Wide-field fundus photograph of an infant; captured with the Phoenix ICON (100° field of view); 1240x1240.
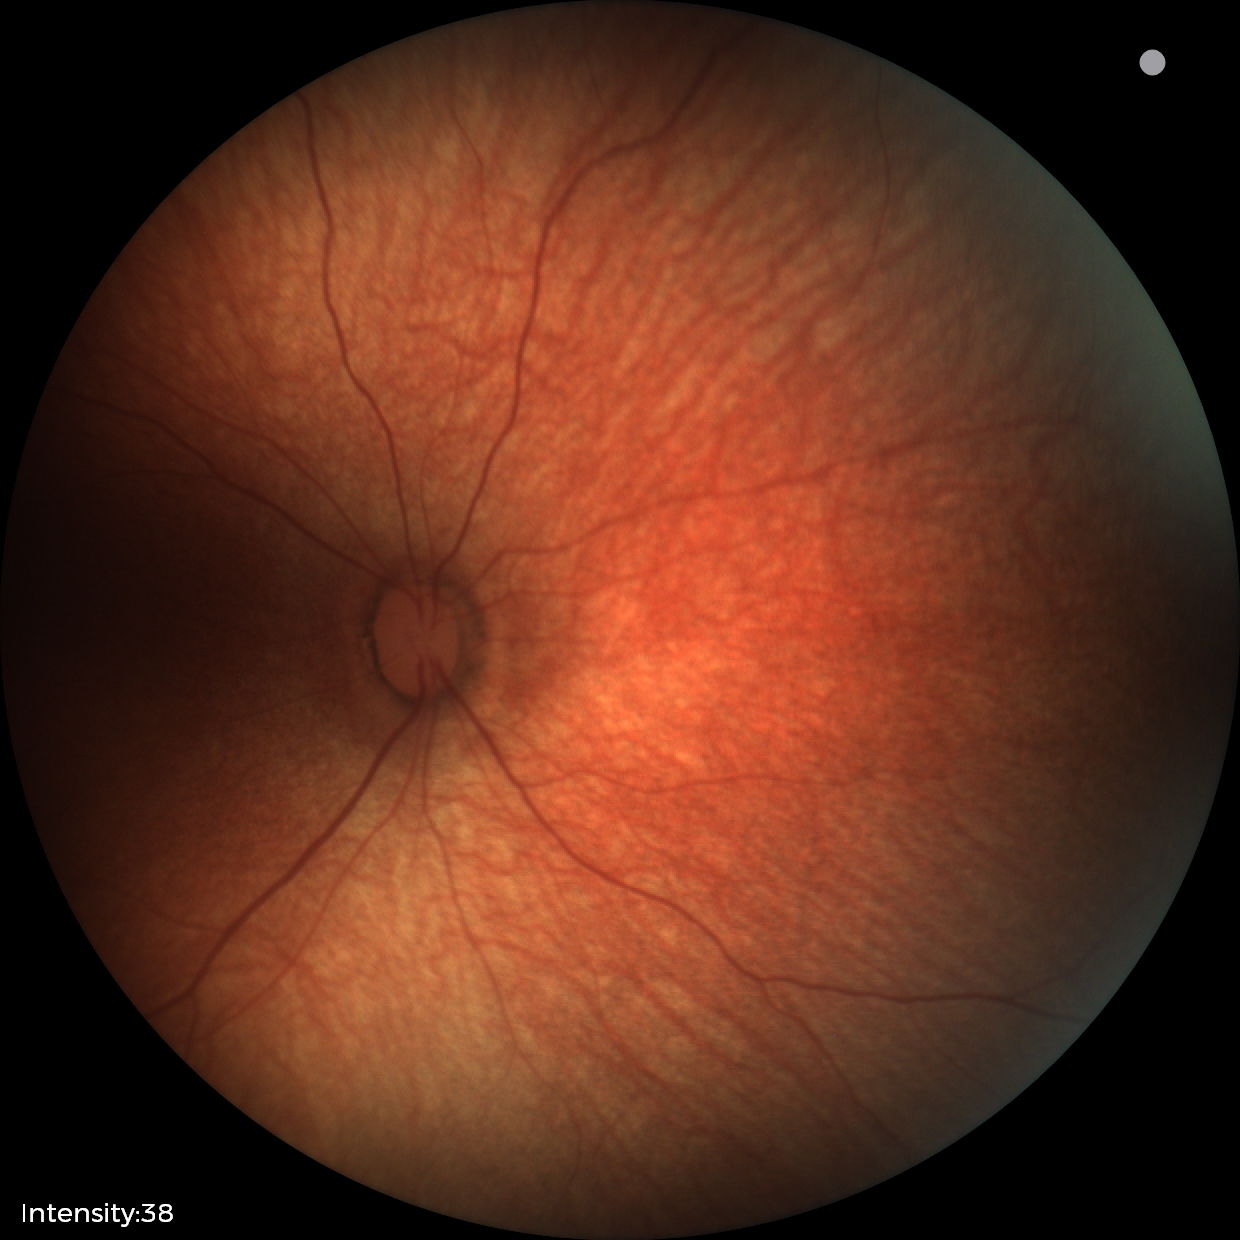

No retinal pathology identified on screening.